Acquired with a NIDEK AFC-230.
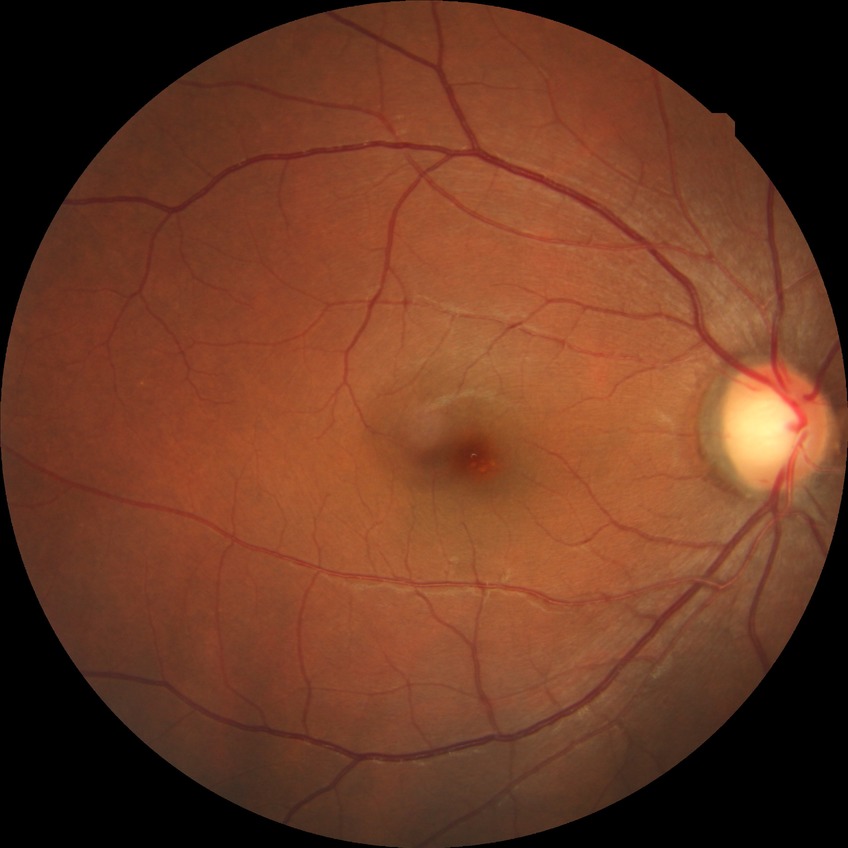

No apparent diabetic retinopathy.
Davis stage: NDR.